Davis DR grading:
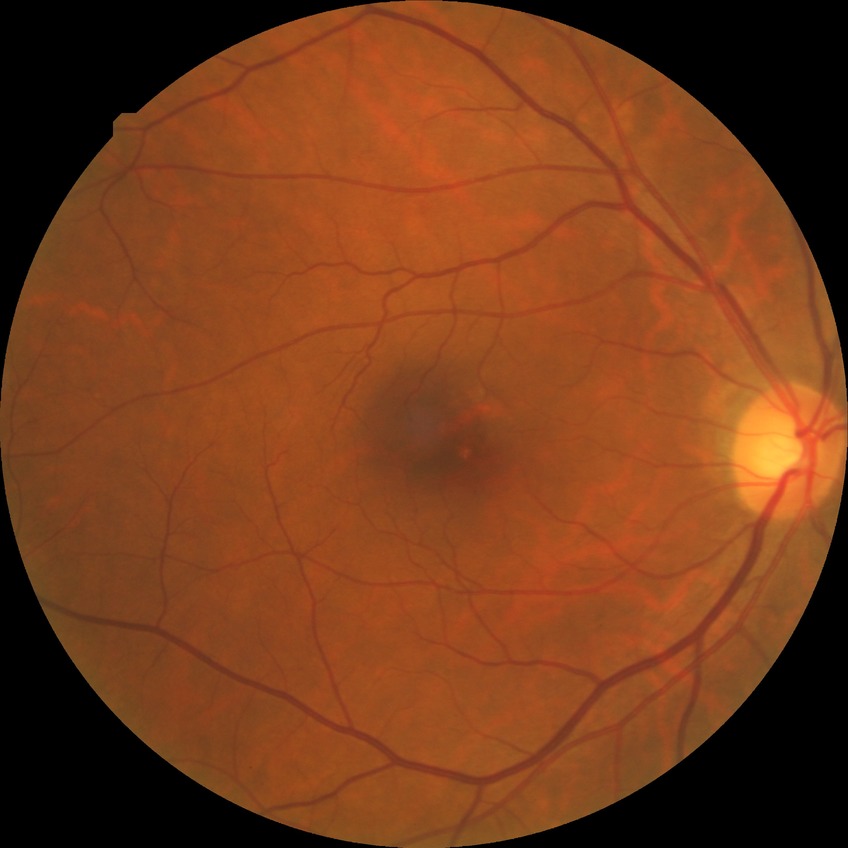
Assessment:
* diabetic retinopathy (DR): no diabetic retinopathy (NDR)